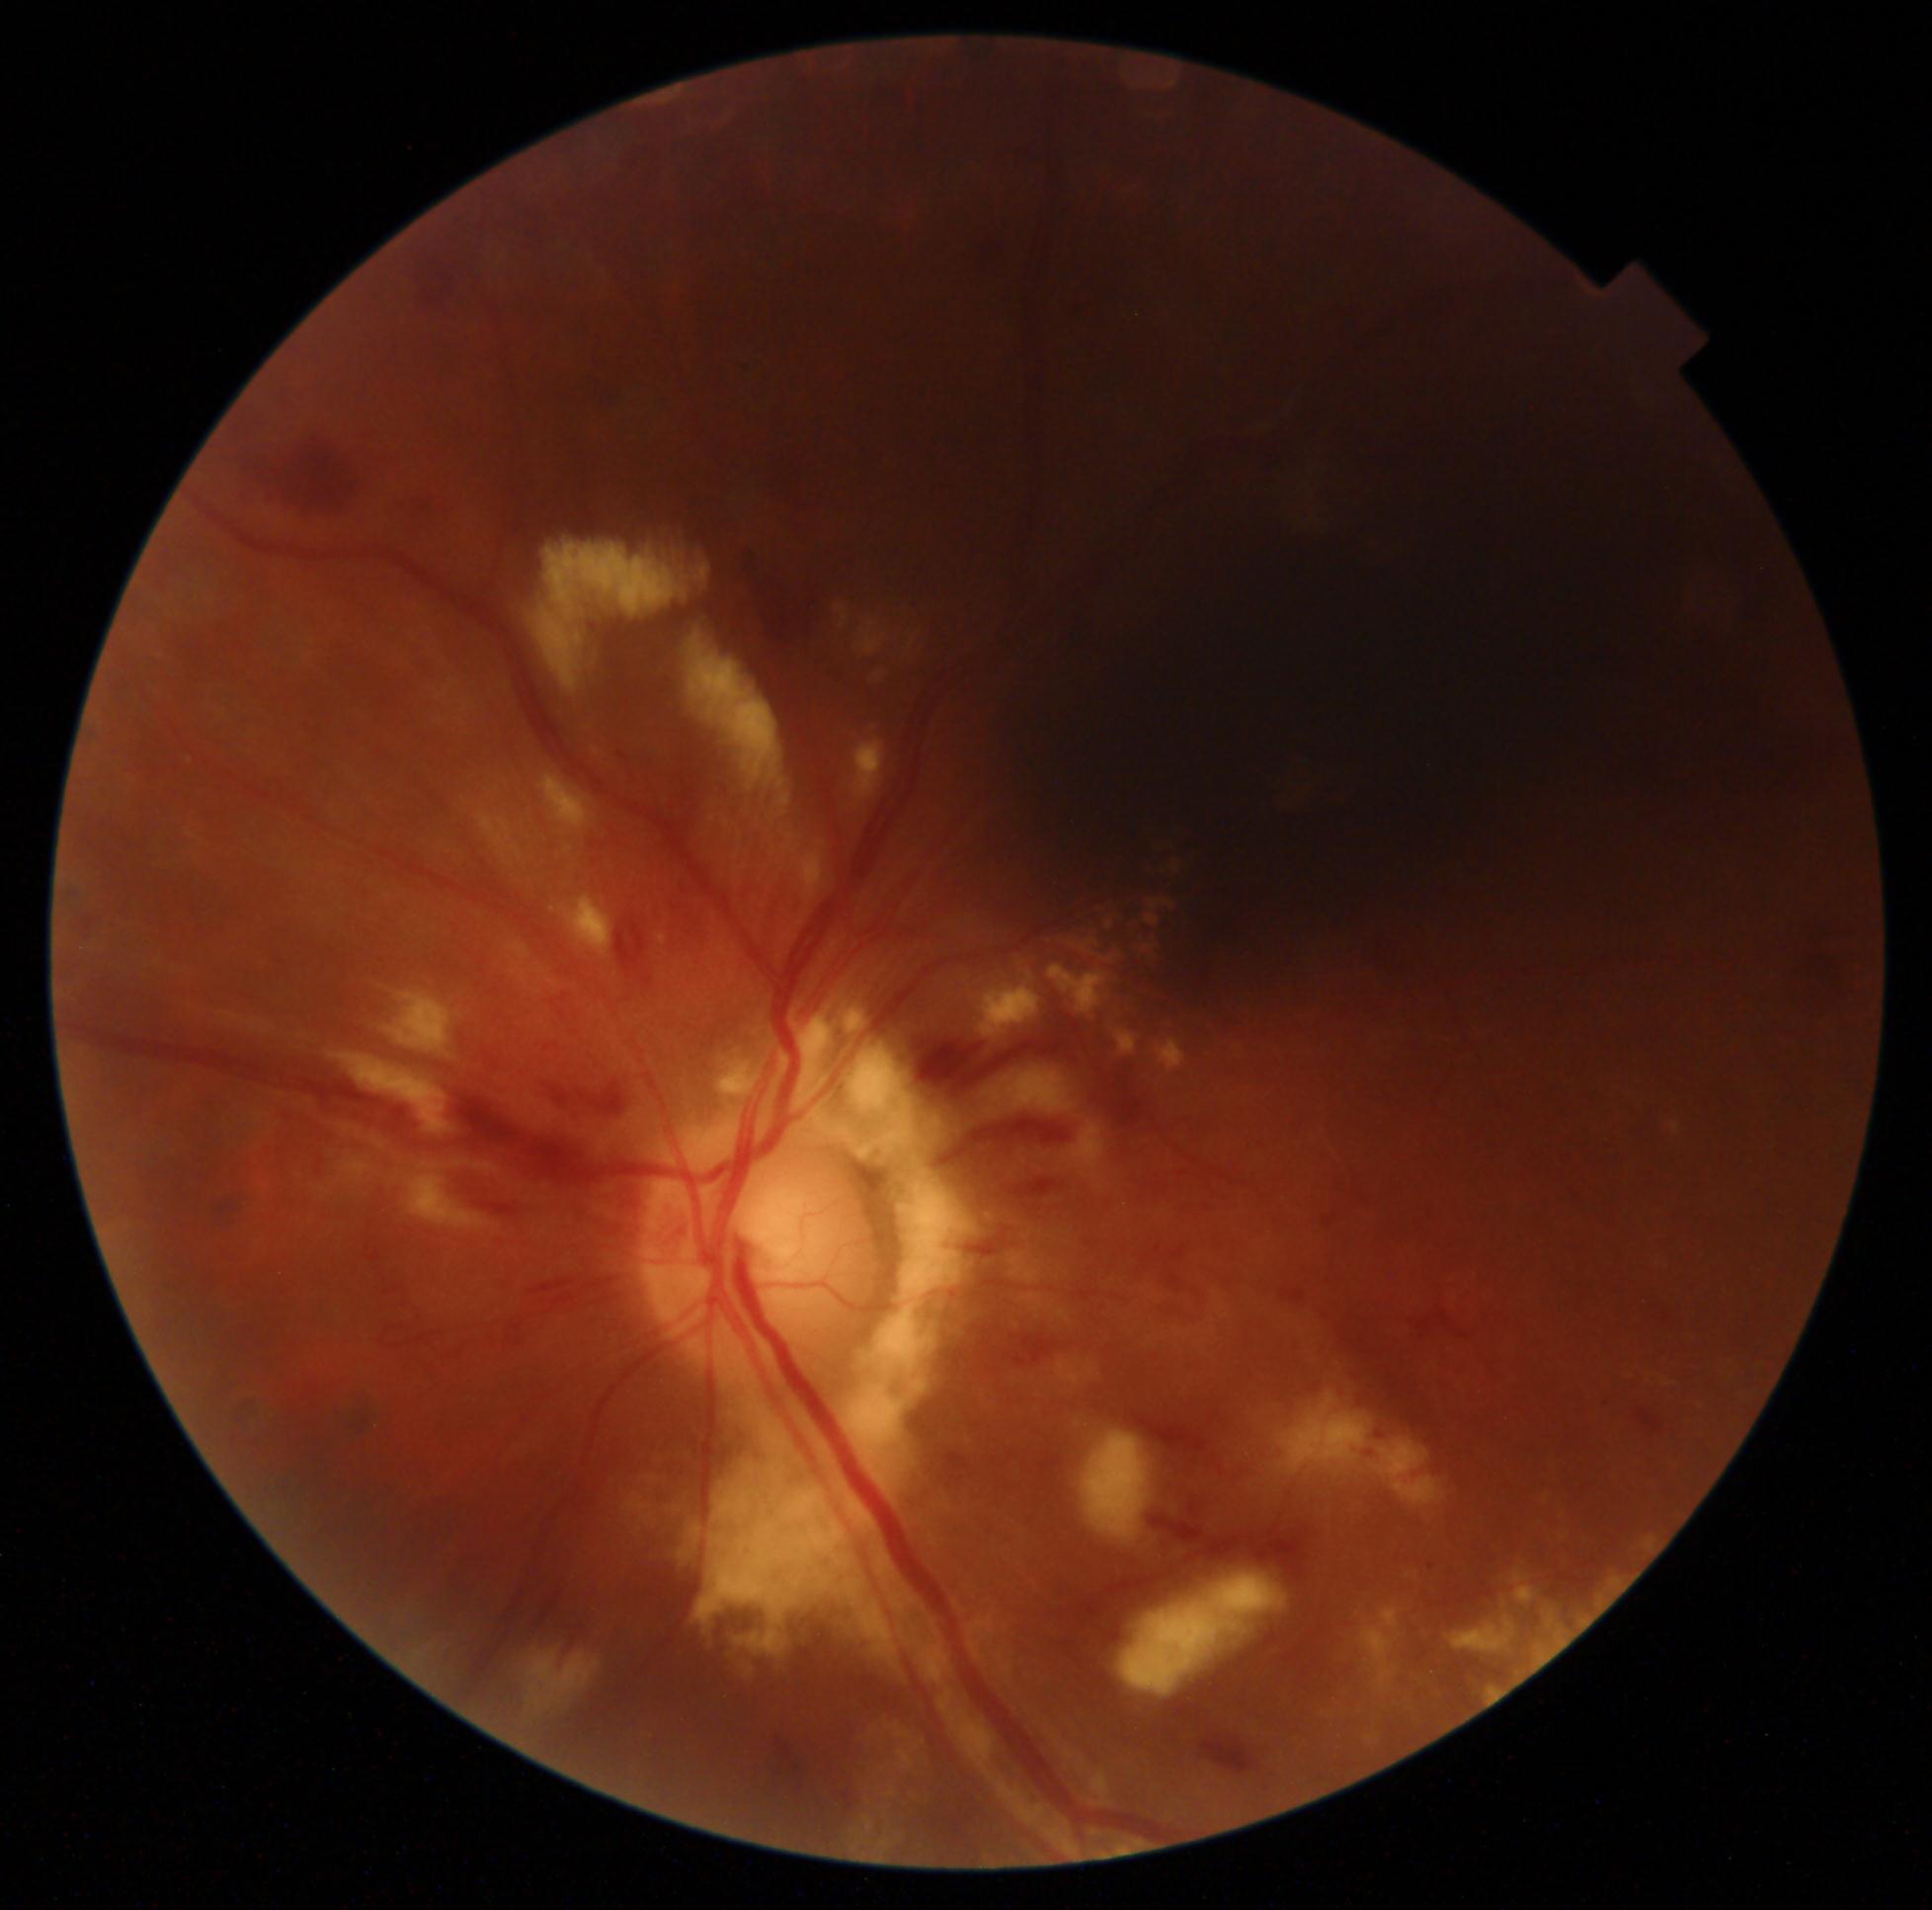
DR severity: grade 2.